Infant wide-field retinal image
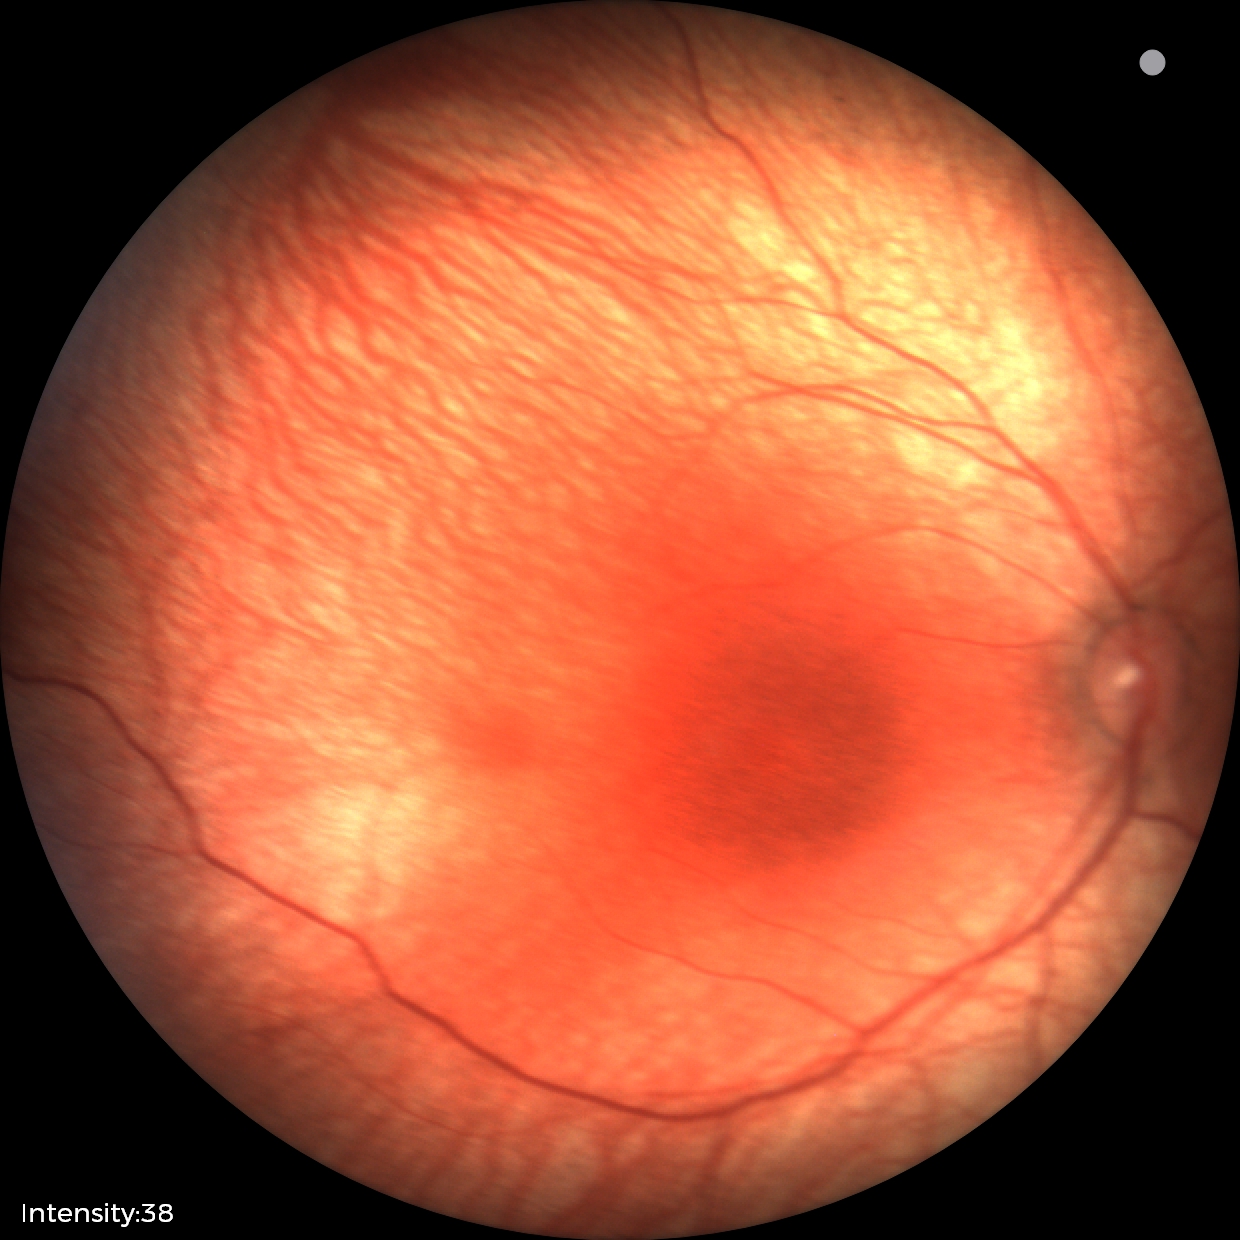
Screening examination diagnosed as physiological.